FOV: 200 degrees. UWF retinal mosaic.
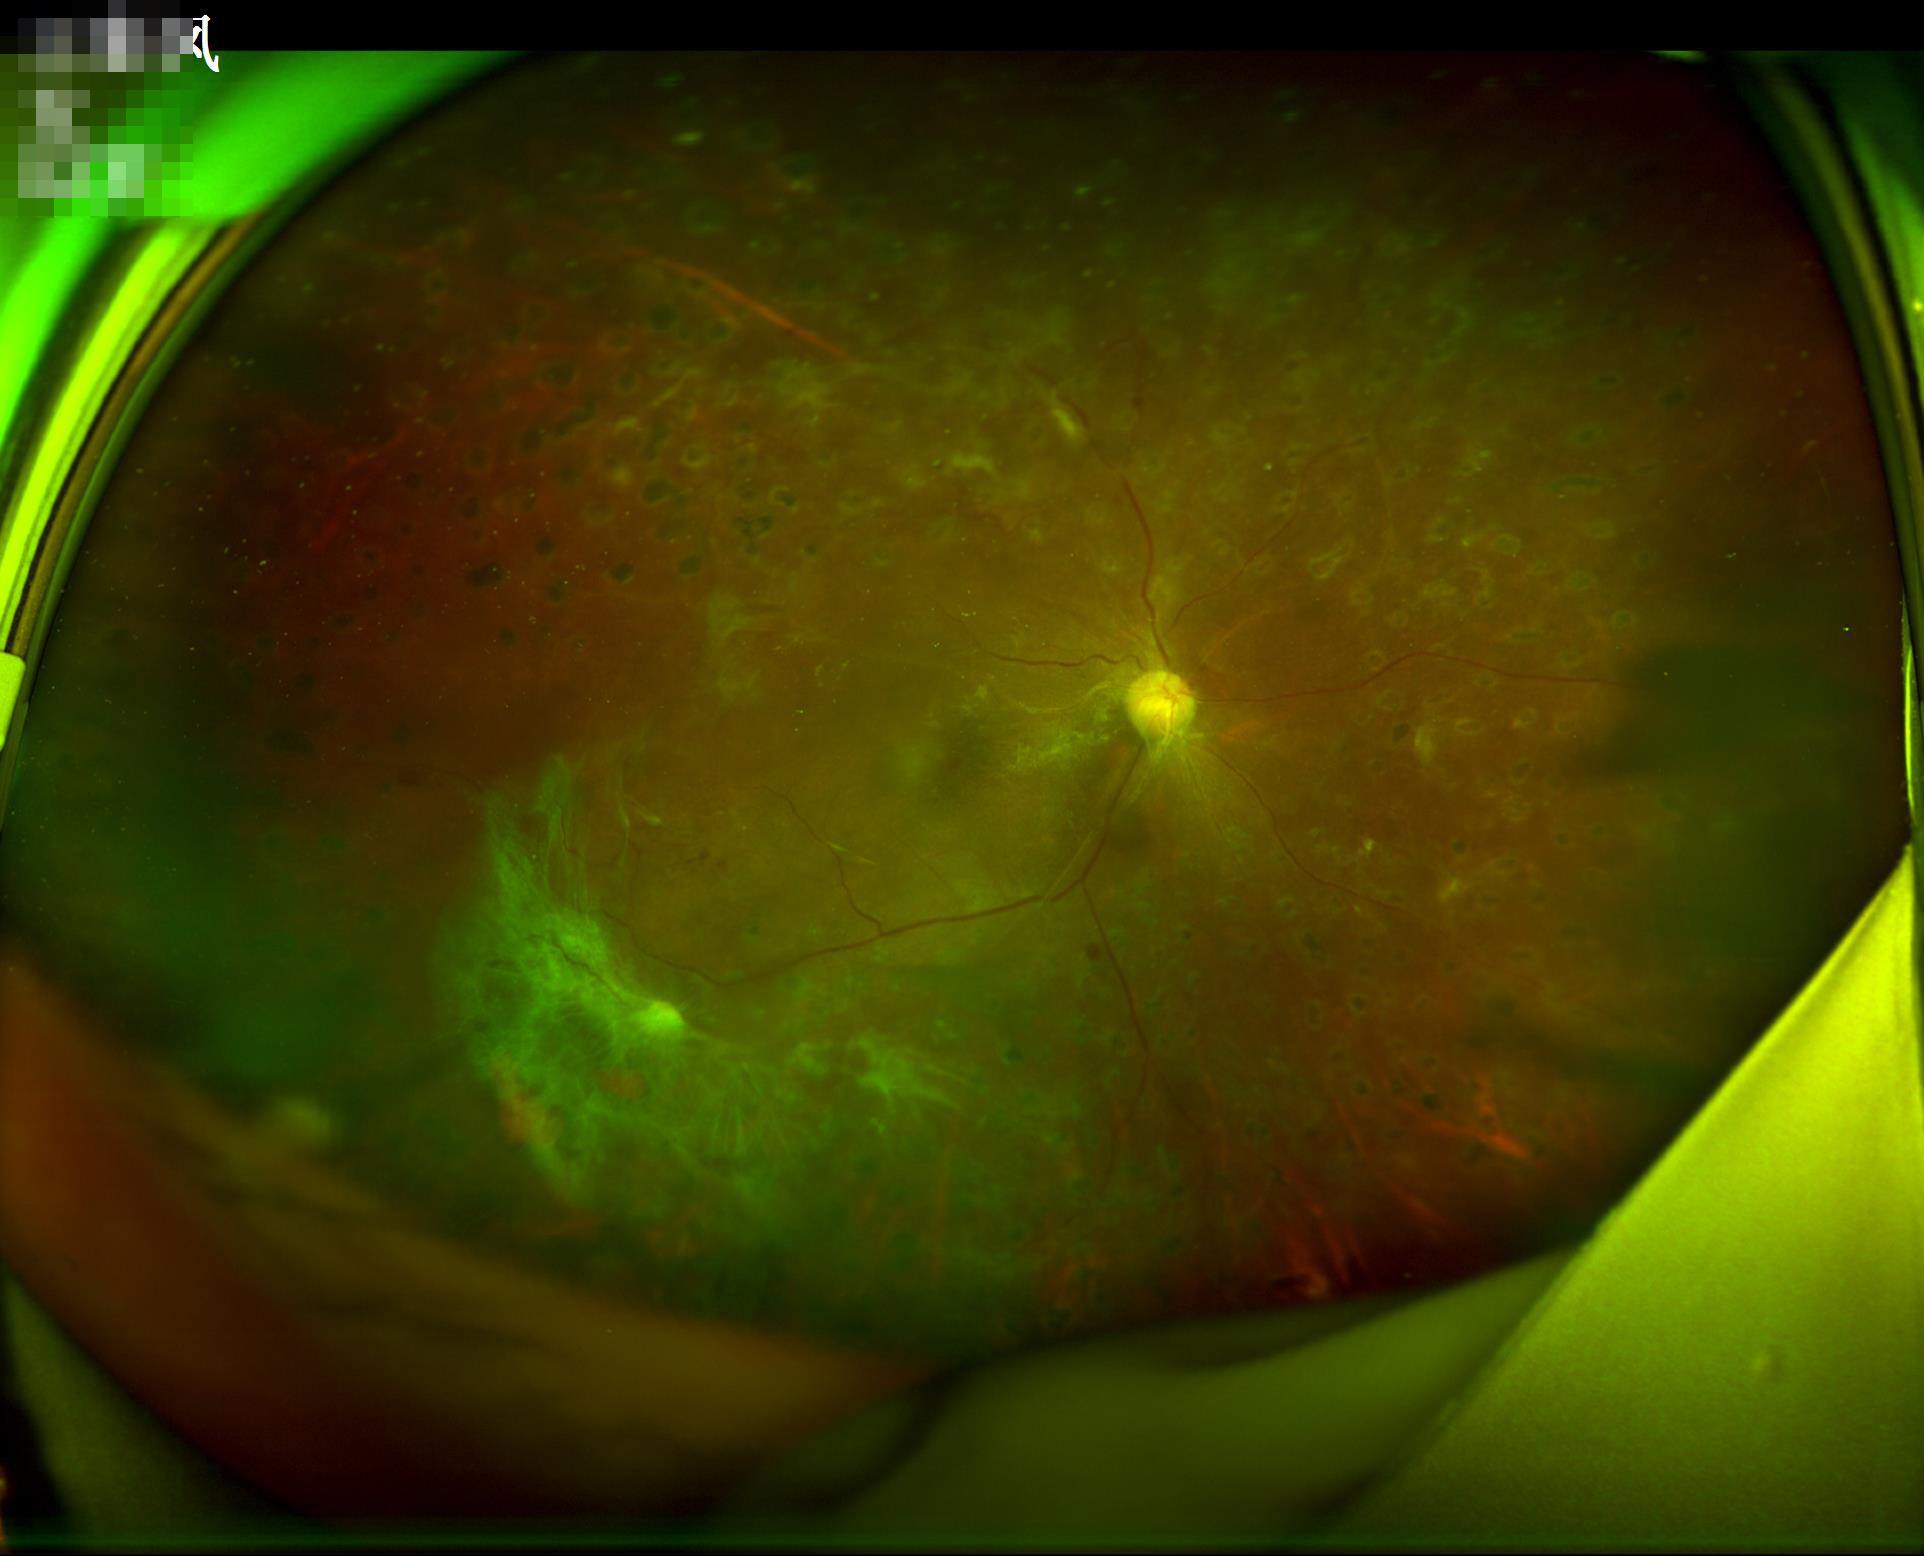

Image quality is inadequate for diagnostic use. Good dynamic range. Illumination is uneven. Noticeable blur in the optic disc, vessels, or background.